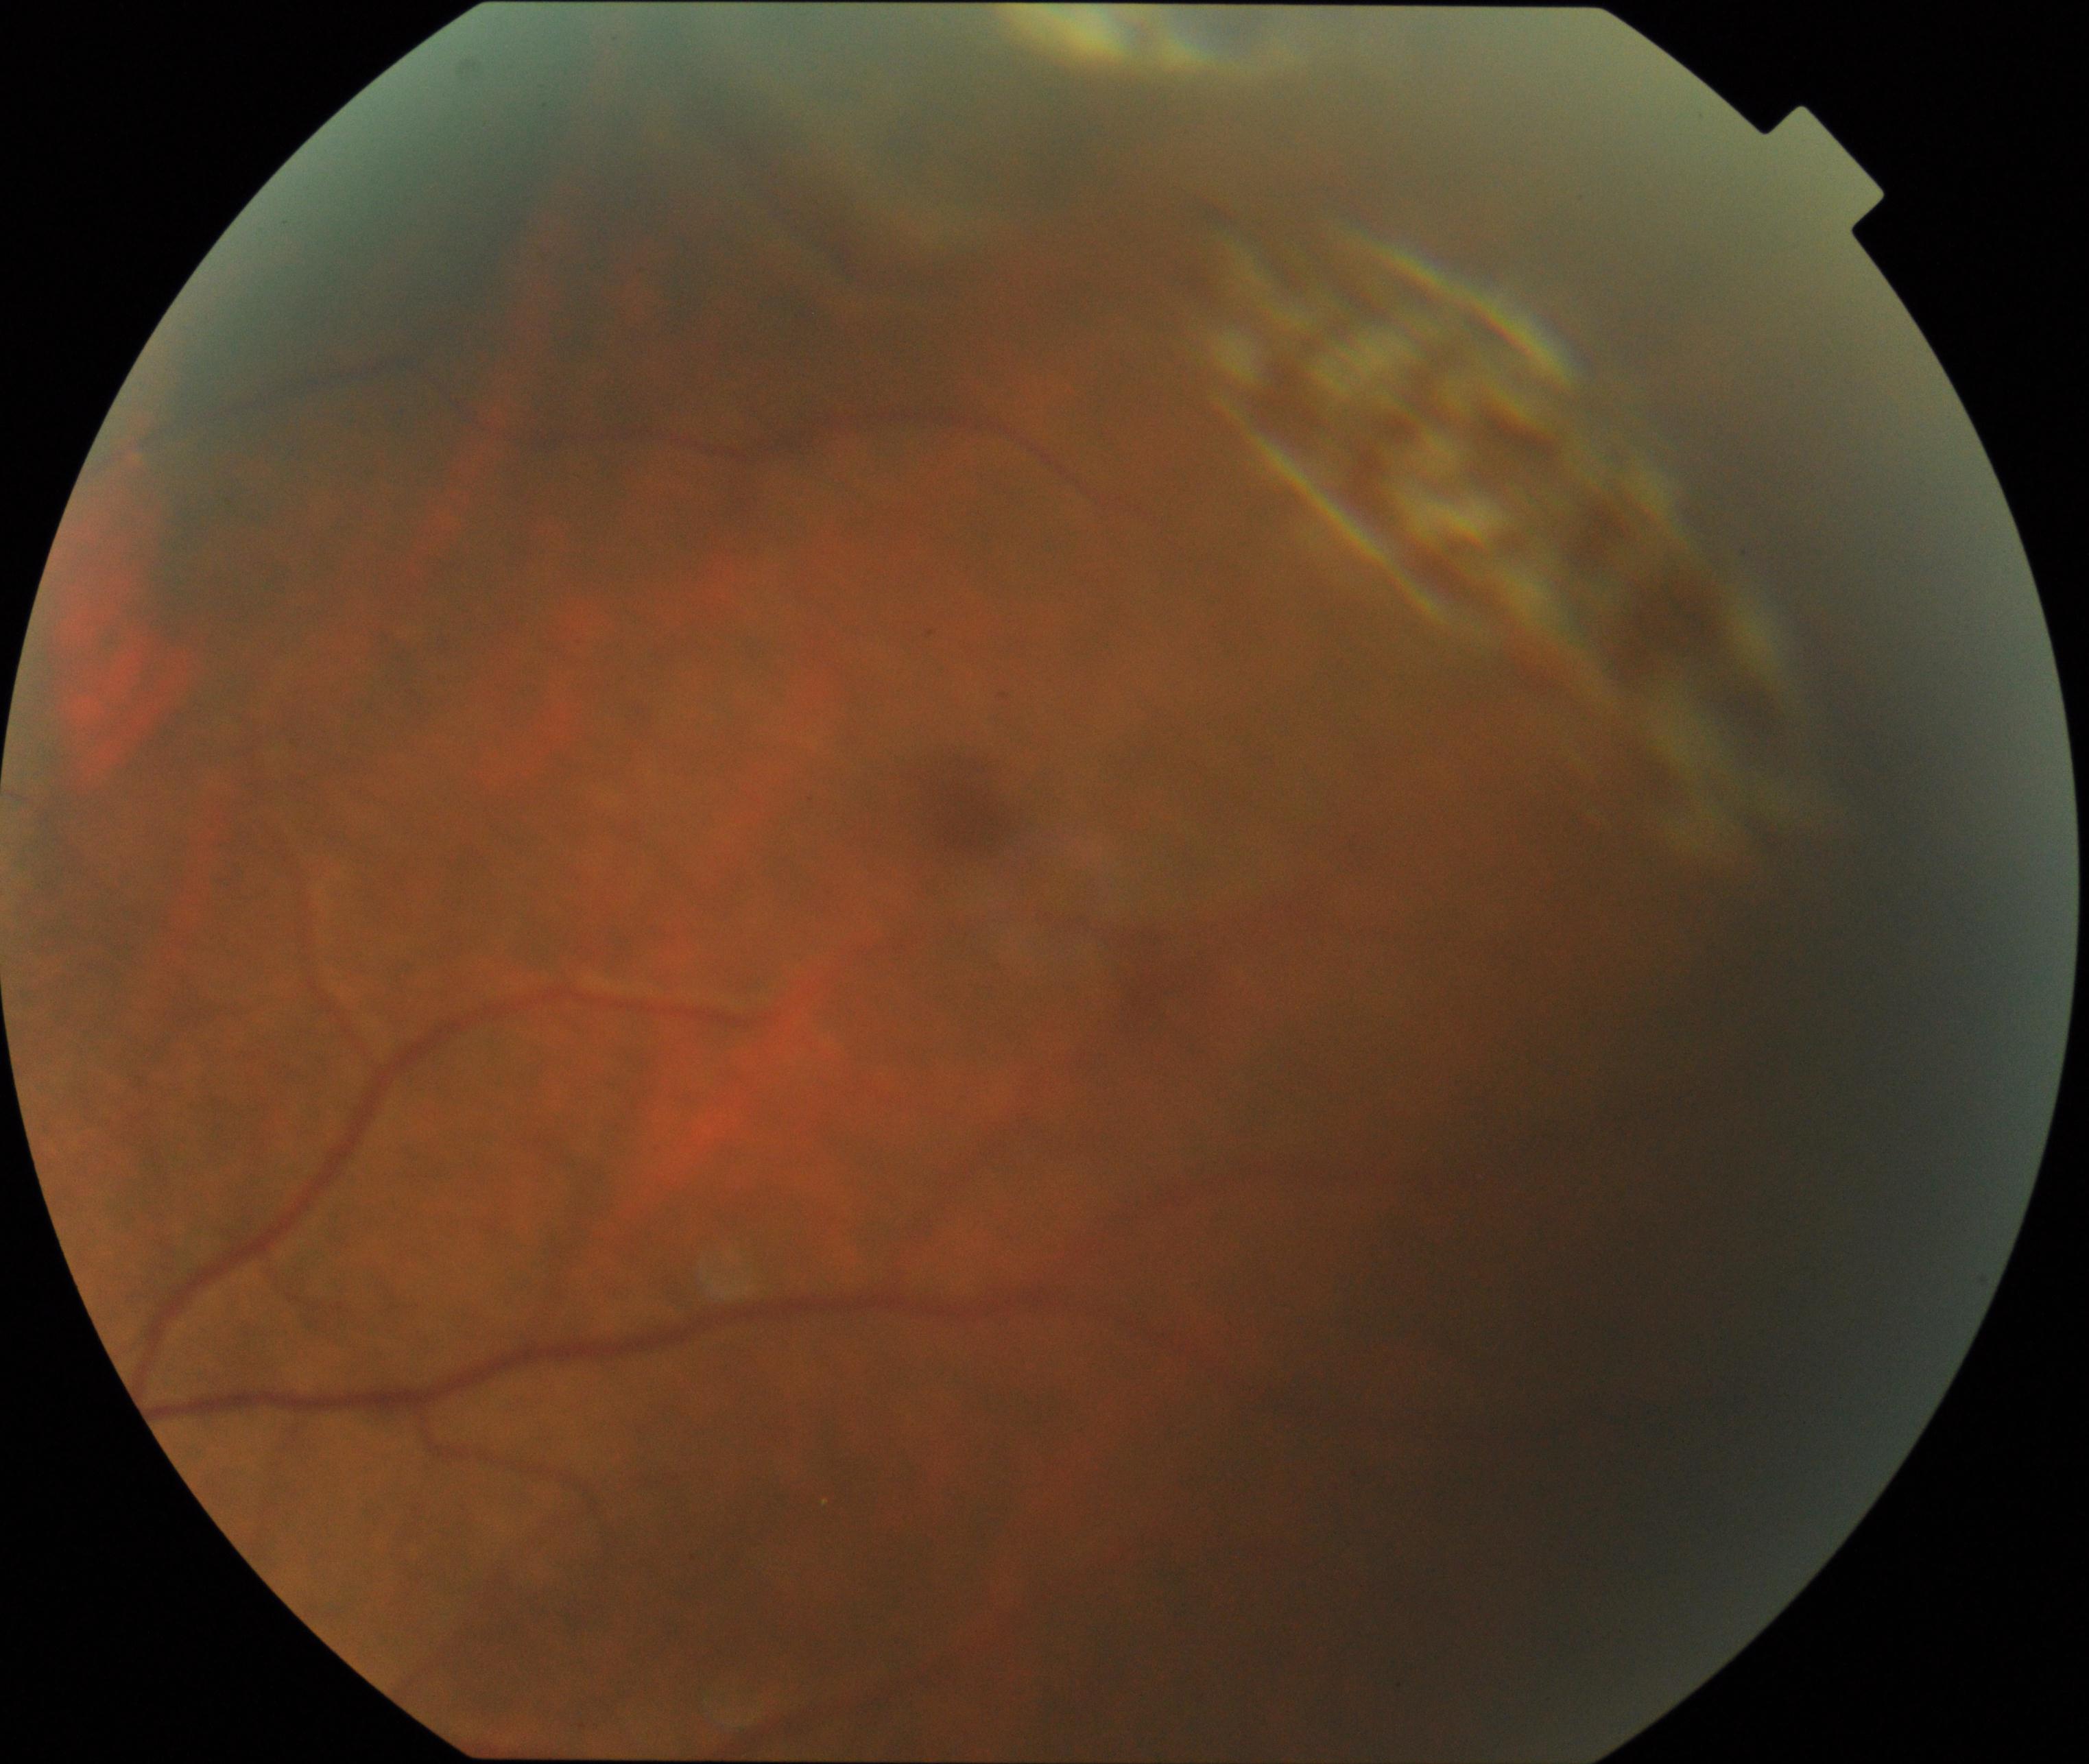 Classification: peripheral retinal degeneration and break.